45° FOV — 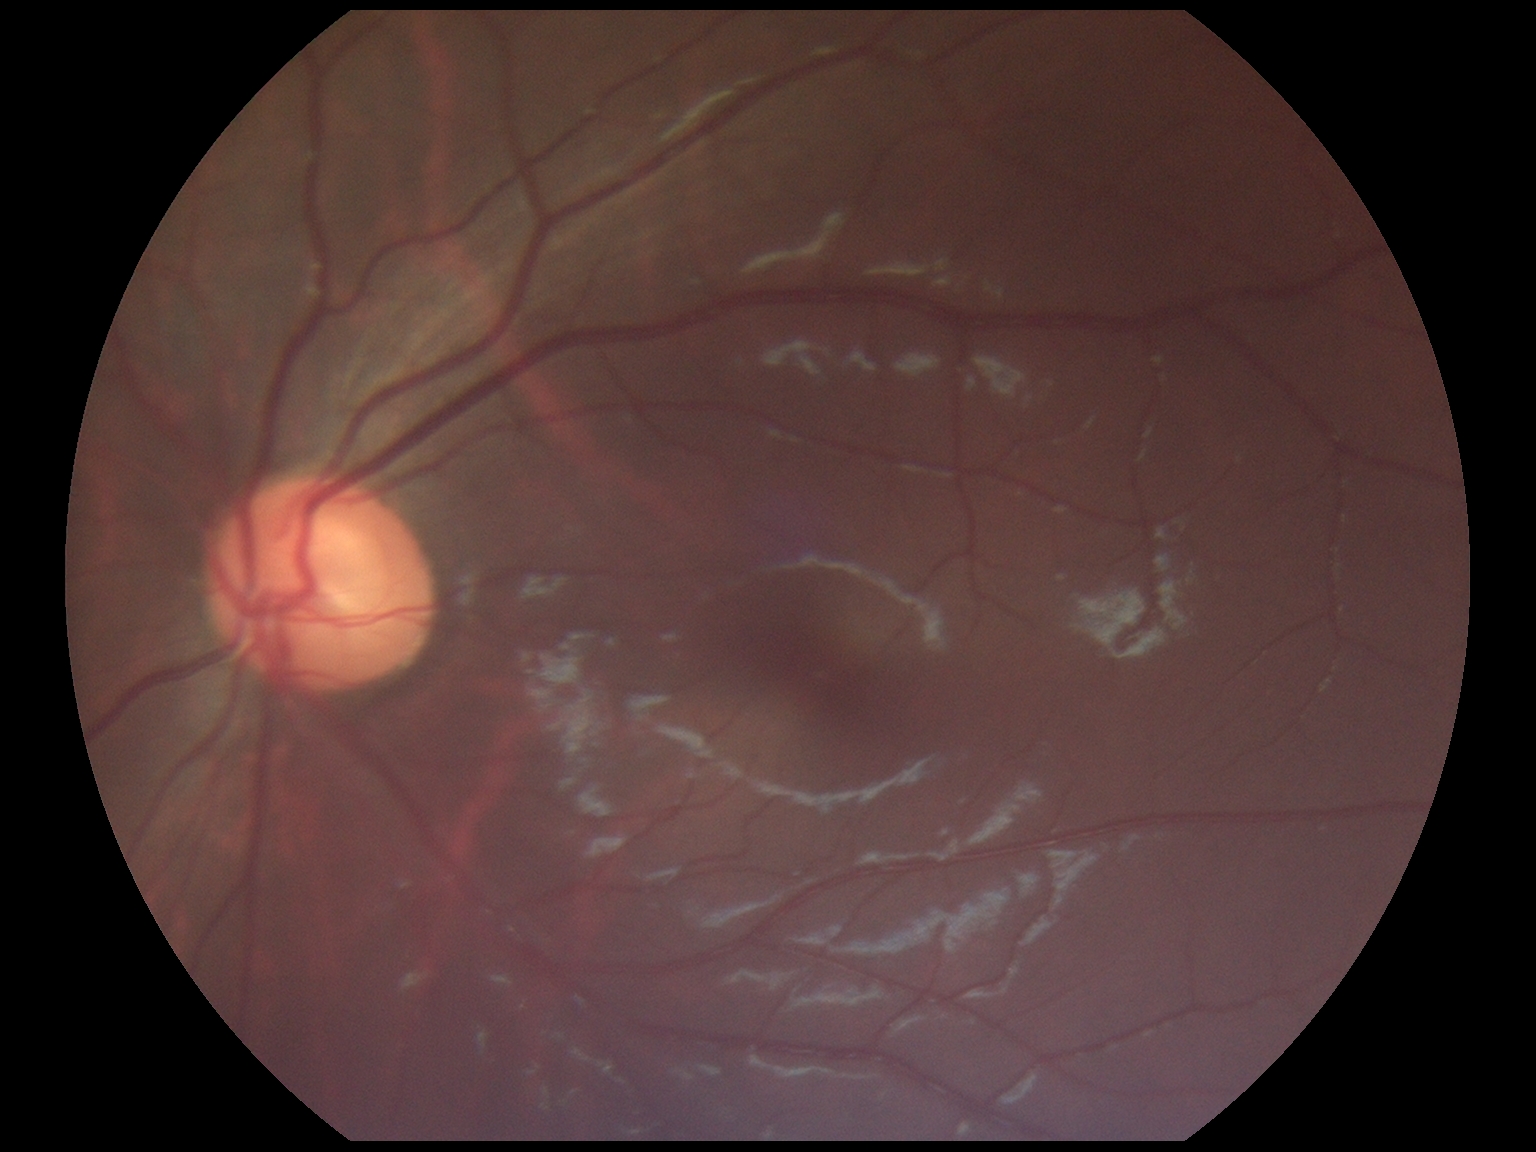

No signs of diabetic retinopathy. Retinopathy grade is 0 — no visible signs of diabetic retinopathy.